45-degree field of view, no pharmacologic dilation, 848x848px, color fundus photograph.
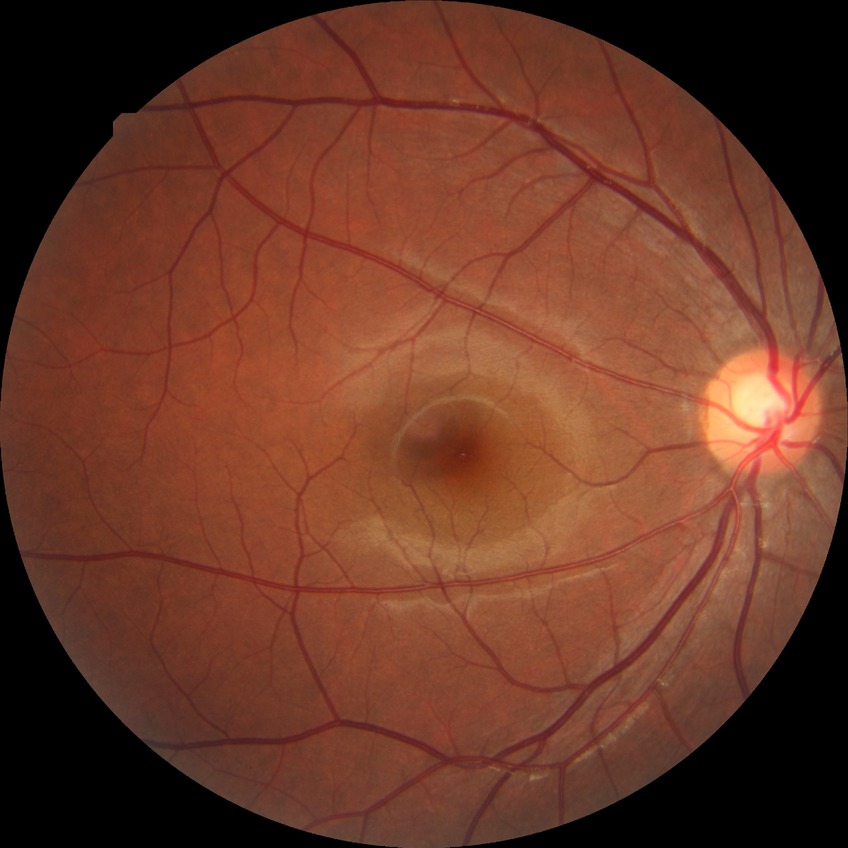

DR impression = no DR findings
Davis stage = NDR